FOV: 45 degrees, nonmydriatic fundus photograph.
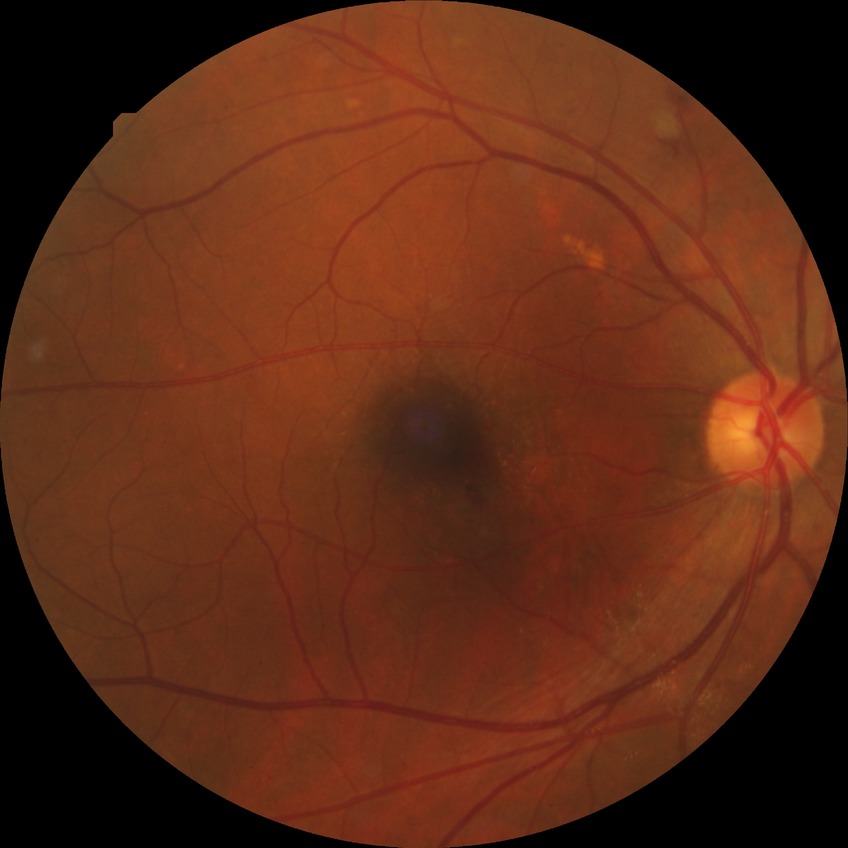
Retinopathy stage is pre-proliferative diabetic retinopathy.